1440x1080 · captured with the Natus RetCam Envision (130° field of view) · infant wide-field fundus photograph — 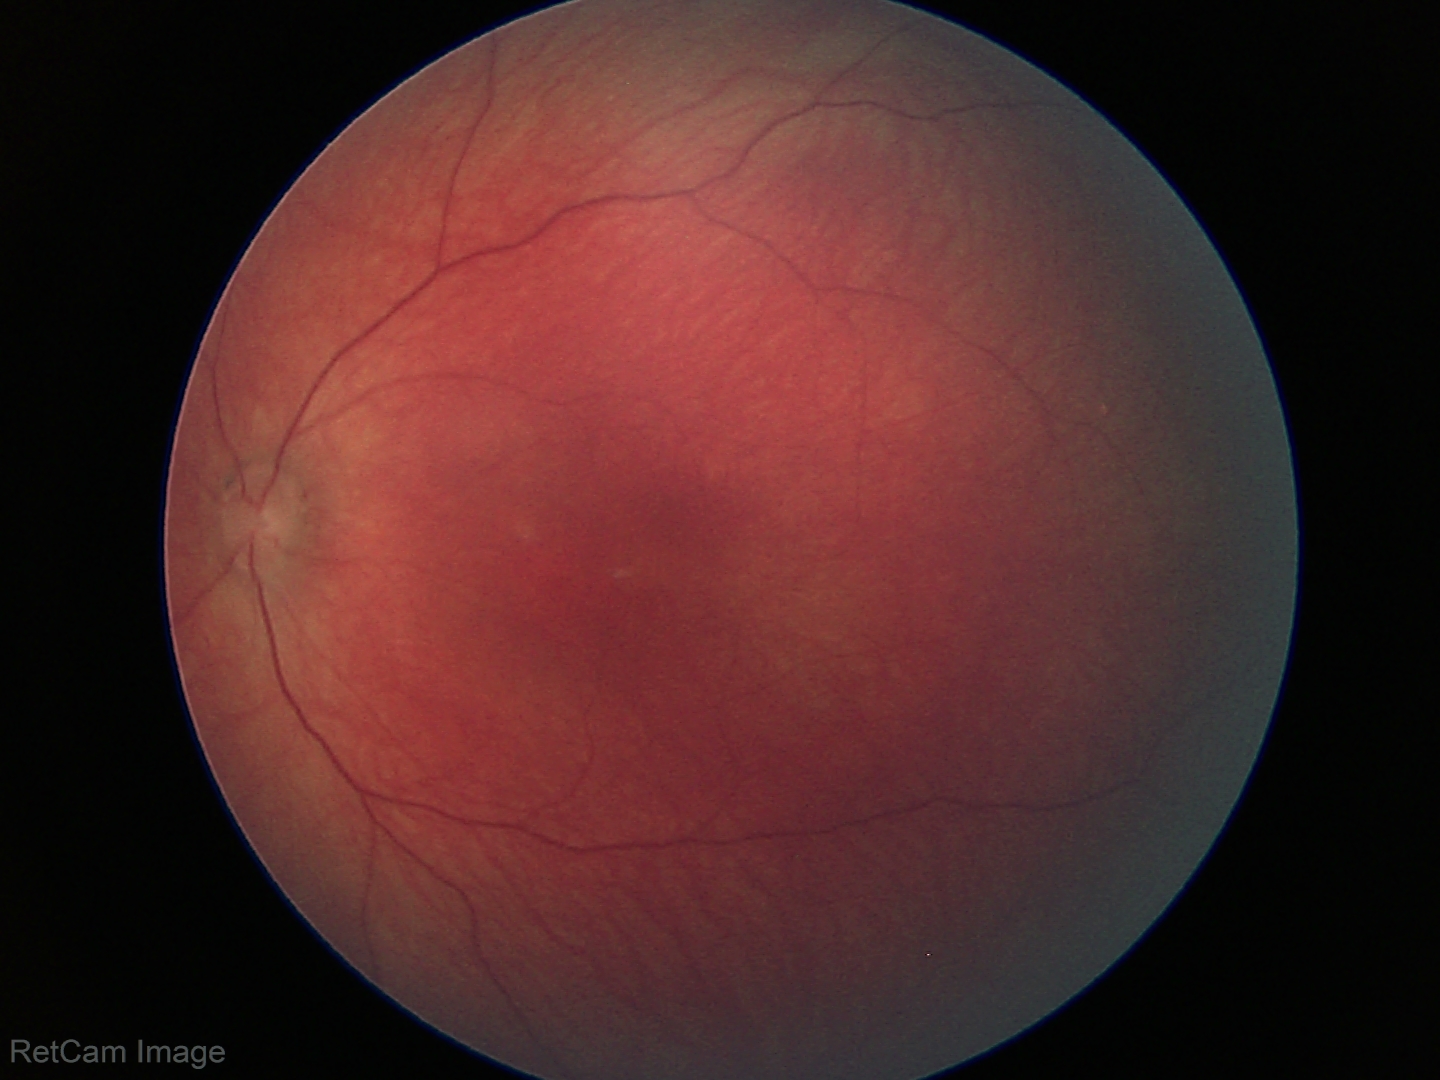
Screening examination diagnosed as physiological.